Optic disc region of a color fundus photo · image size 349x349 — 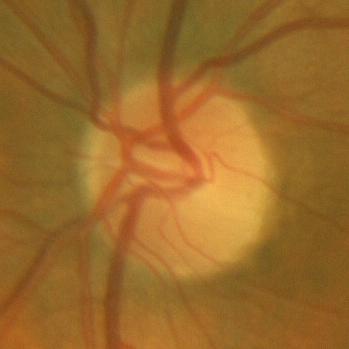 Optic disc appearance consistent with no glaucomatous changes.